1932 x 1932 pixels: 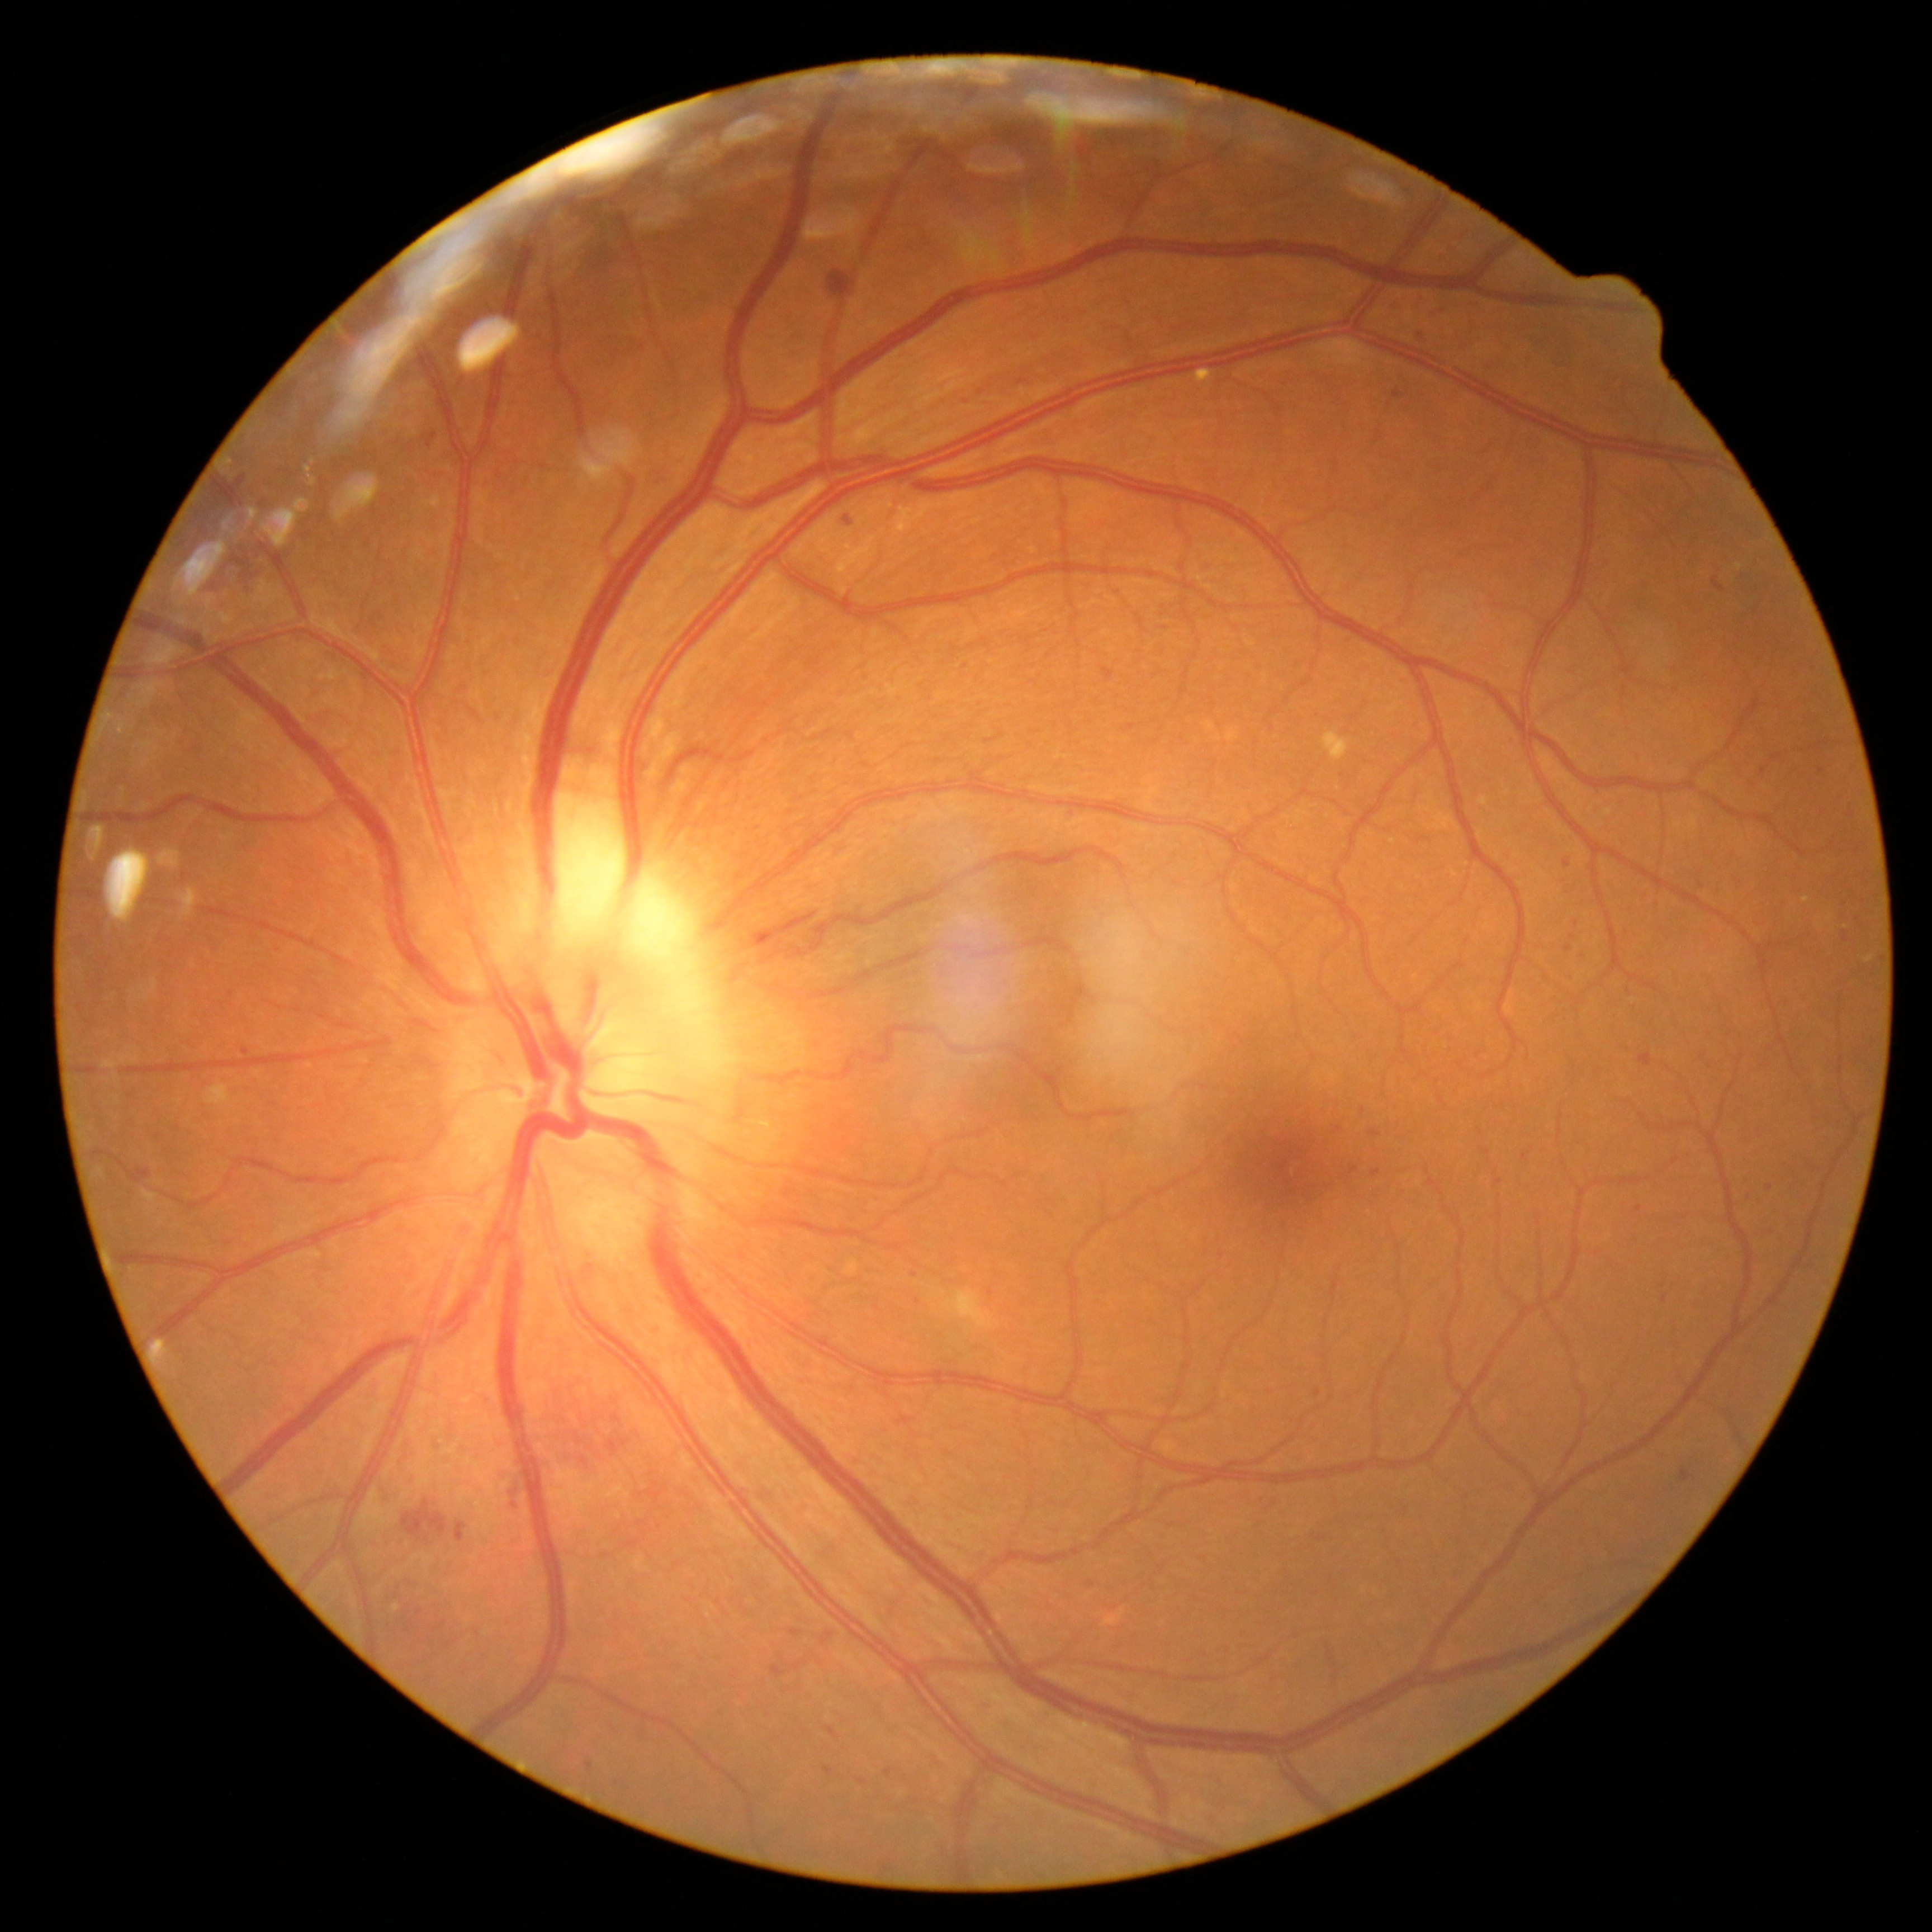 Retinopathy grade is 2/4
Selected lesions:
• microaneurysms (partial): region(1369, 1131, 1380, 1137); region(822, 1632, 834, 1643); region(771, 1664, 787, 1678); region(825, 1767, 834, 1776); region(1663, 1294, 1668, 1303); region(964, 394, 970, 404); region(886, 1768, 893, 1777); region(1581, 949, 1589, 959); region(1393, 392, 1401, 400); region(1681, 1471, 1691, 1481); region(428, 433, 438, 448); region(825, 1726, 839, 1738)
• Smaller microaneurysms around <point>1663, 1285</point>; <point>1525, 1157</point>; <point>178, 1129</point>; <point>1567, 864</point>; <point>1577, 923</point>; <point>1132, 727</point>; <point>1339, 1129</point>; <point>1821, 771</point>